Fundus photo, 1444 by 1444 pixels.
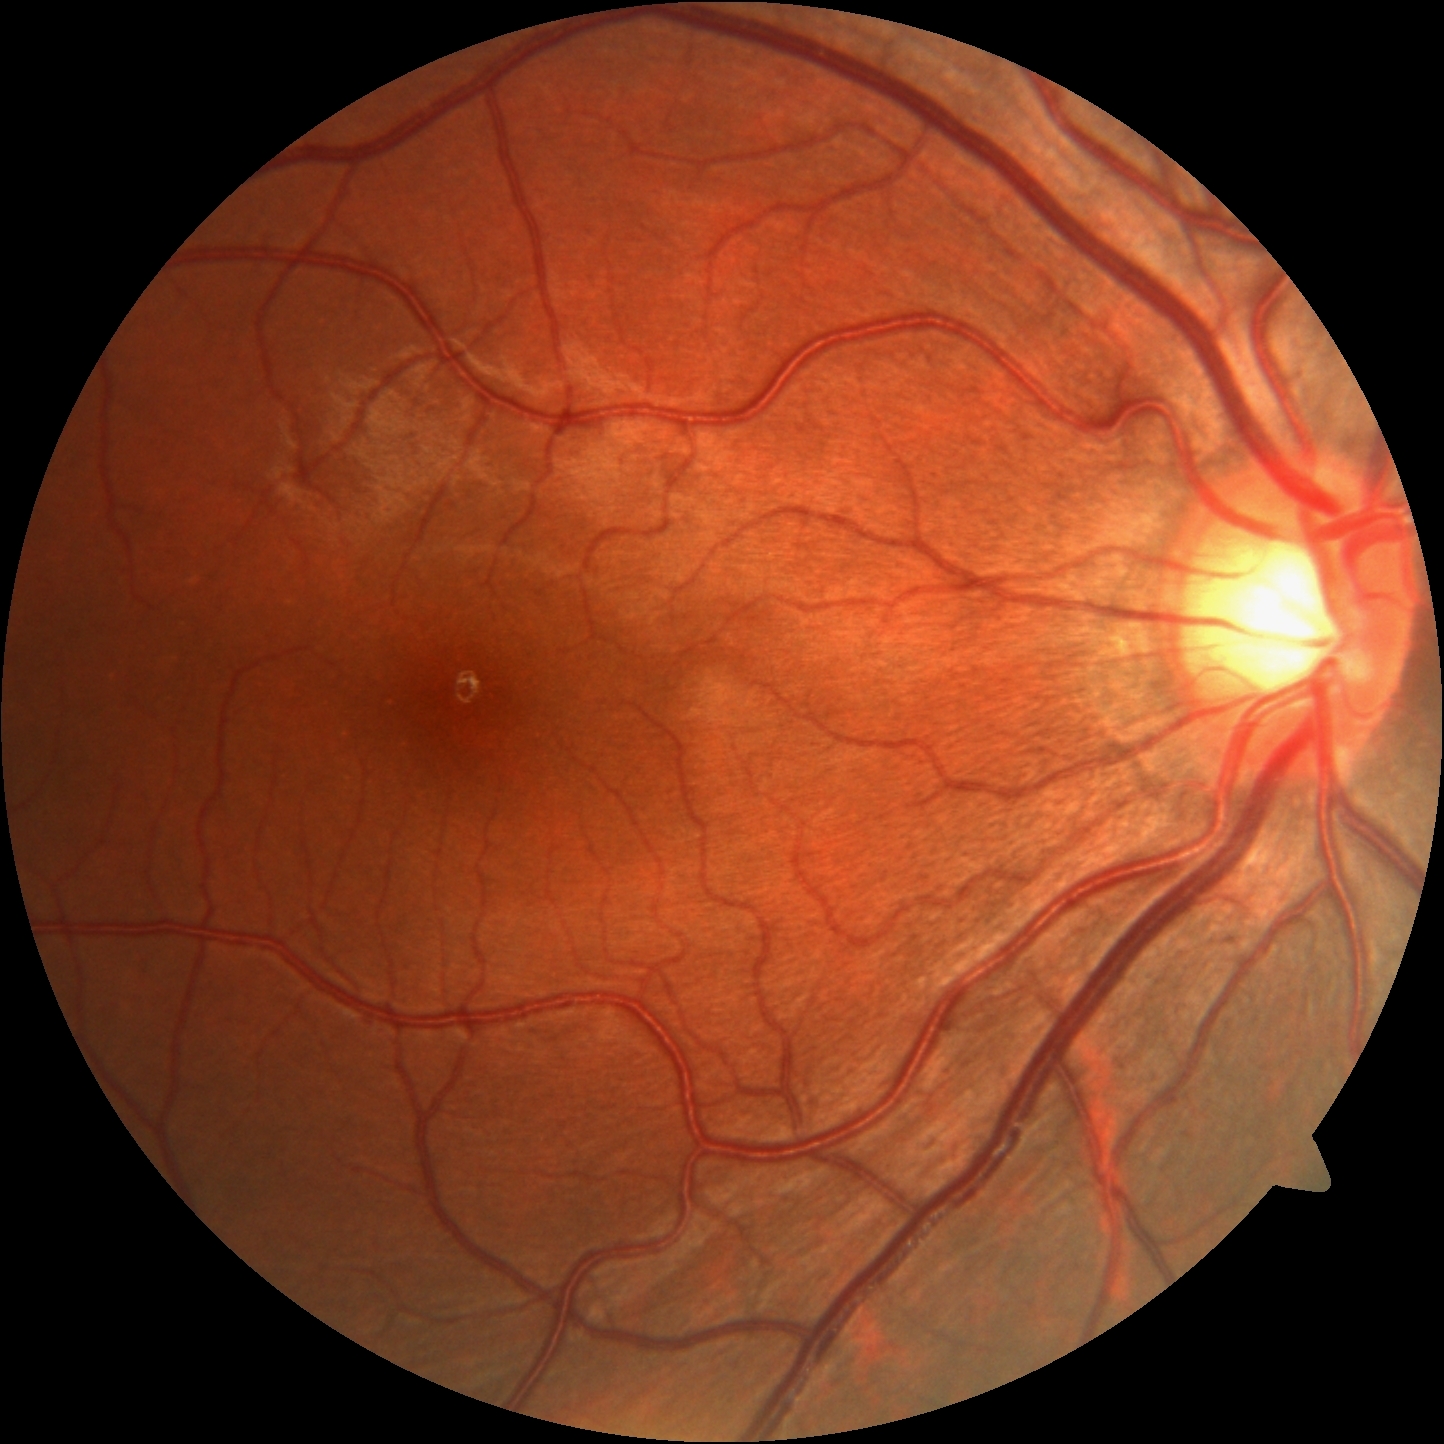

DR stage@no apparent retinopathy (grade 0).